Graded on the modified Davis scale · camera: NIDEK AFC-230 · 45-degree field of view.
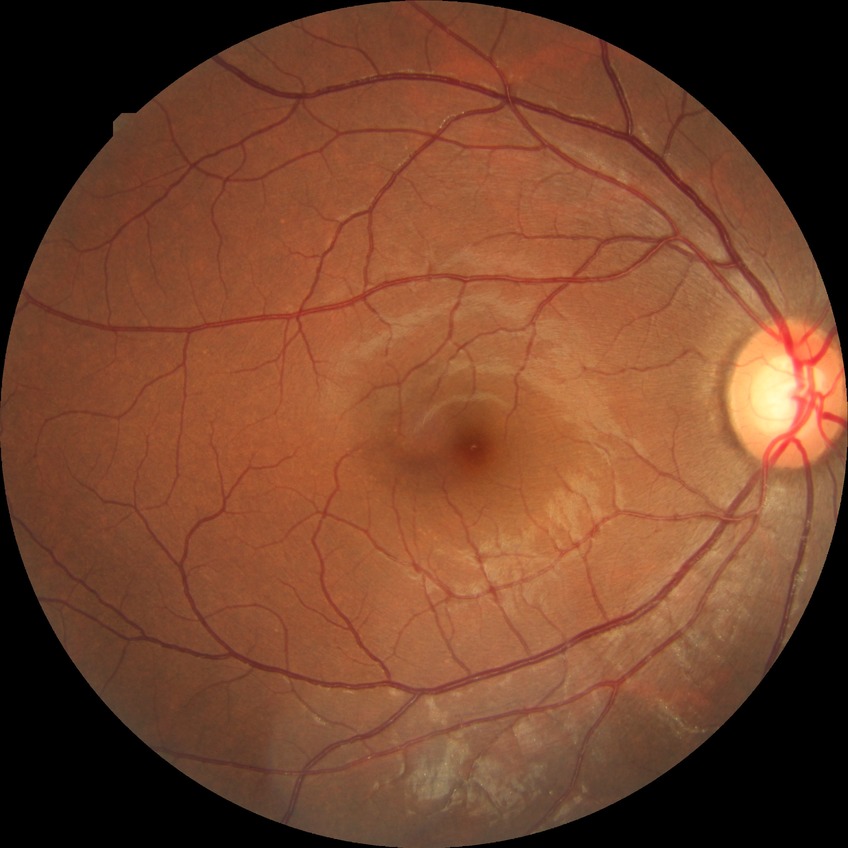 Diabetic retinopathy grade: no diabetic retinopathy.